35° field of view before cropping · ONH-centered crop from a color fundus image · acquired with a Topcon TRC
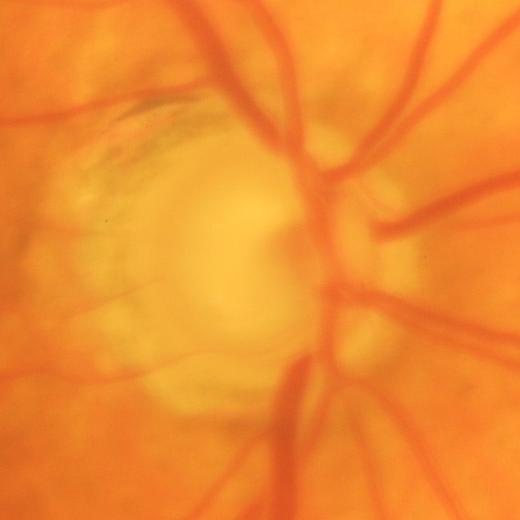 Demonstrates glaucomatous optic neuropathy.